Pediatric wide-field fundus photograph:
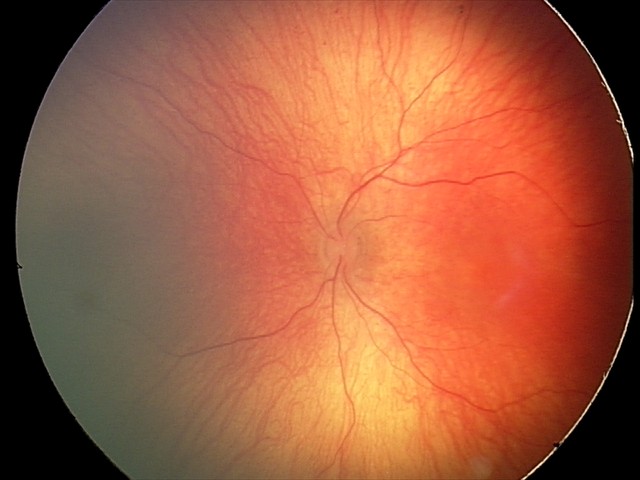 Assessment: no abnormalities